NIDEK AFC-230:
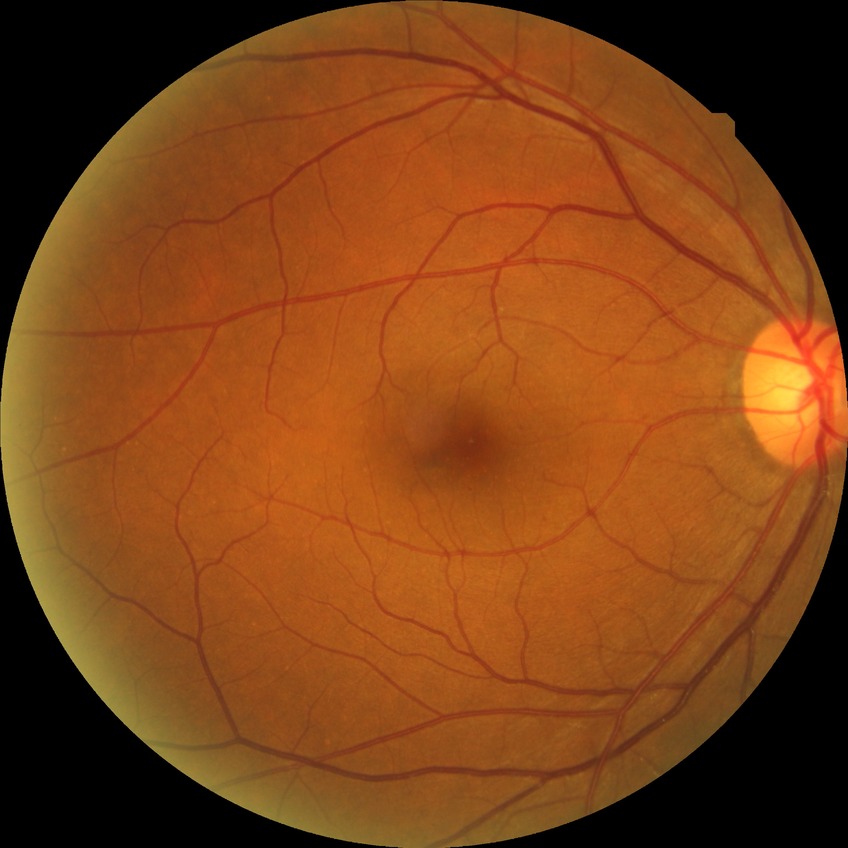

DR class: non-proliferative diabetic retinopathy. Diabetic retinopathy (DR) is simple diabetic retinopathy (SDR).